45° field of view, color fundus image.
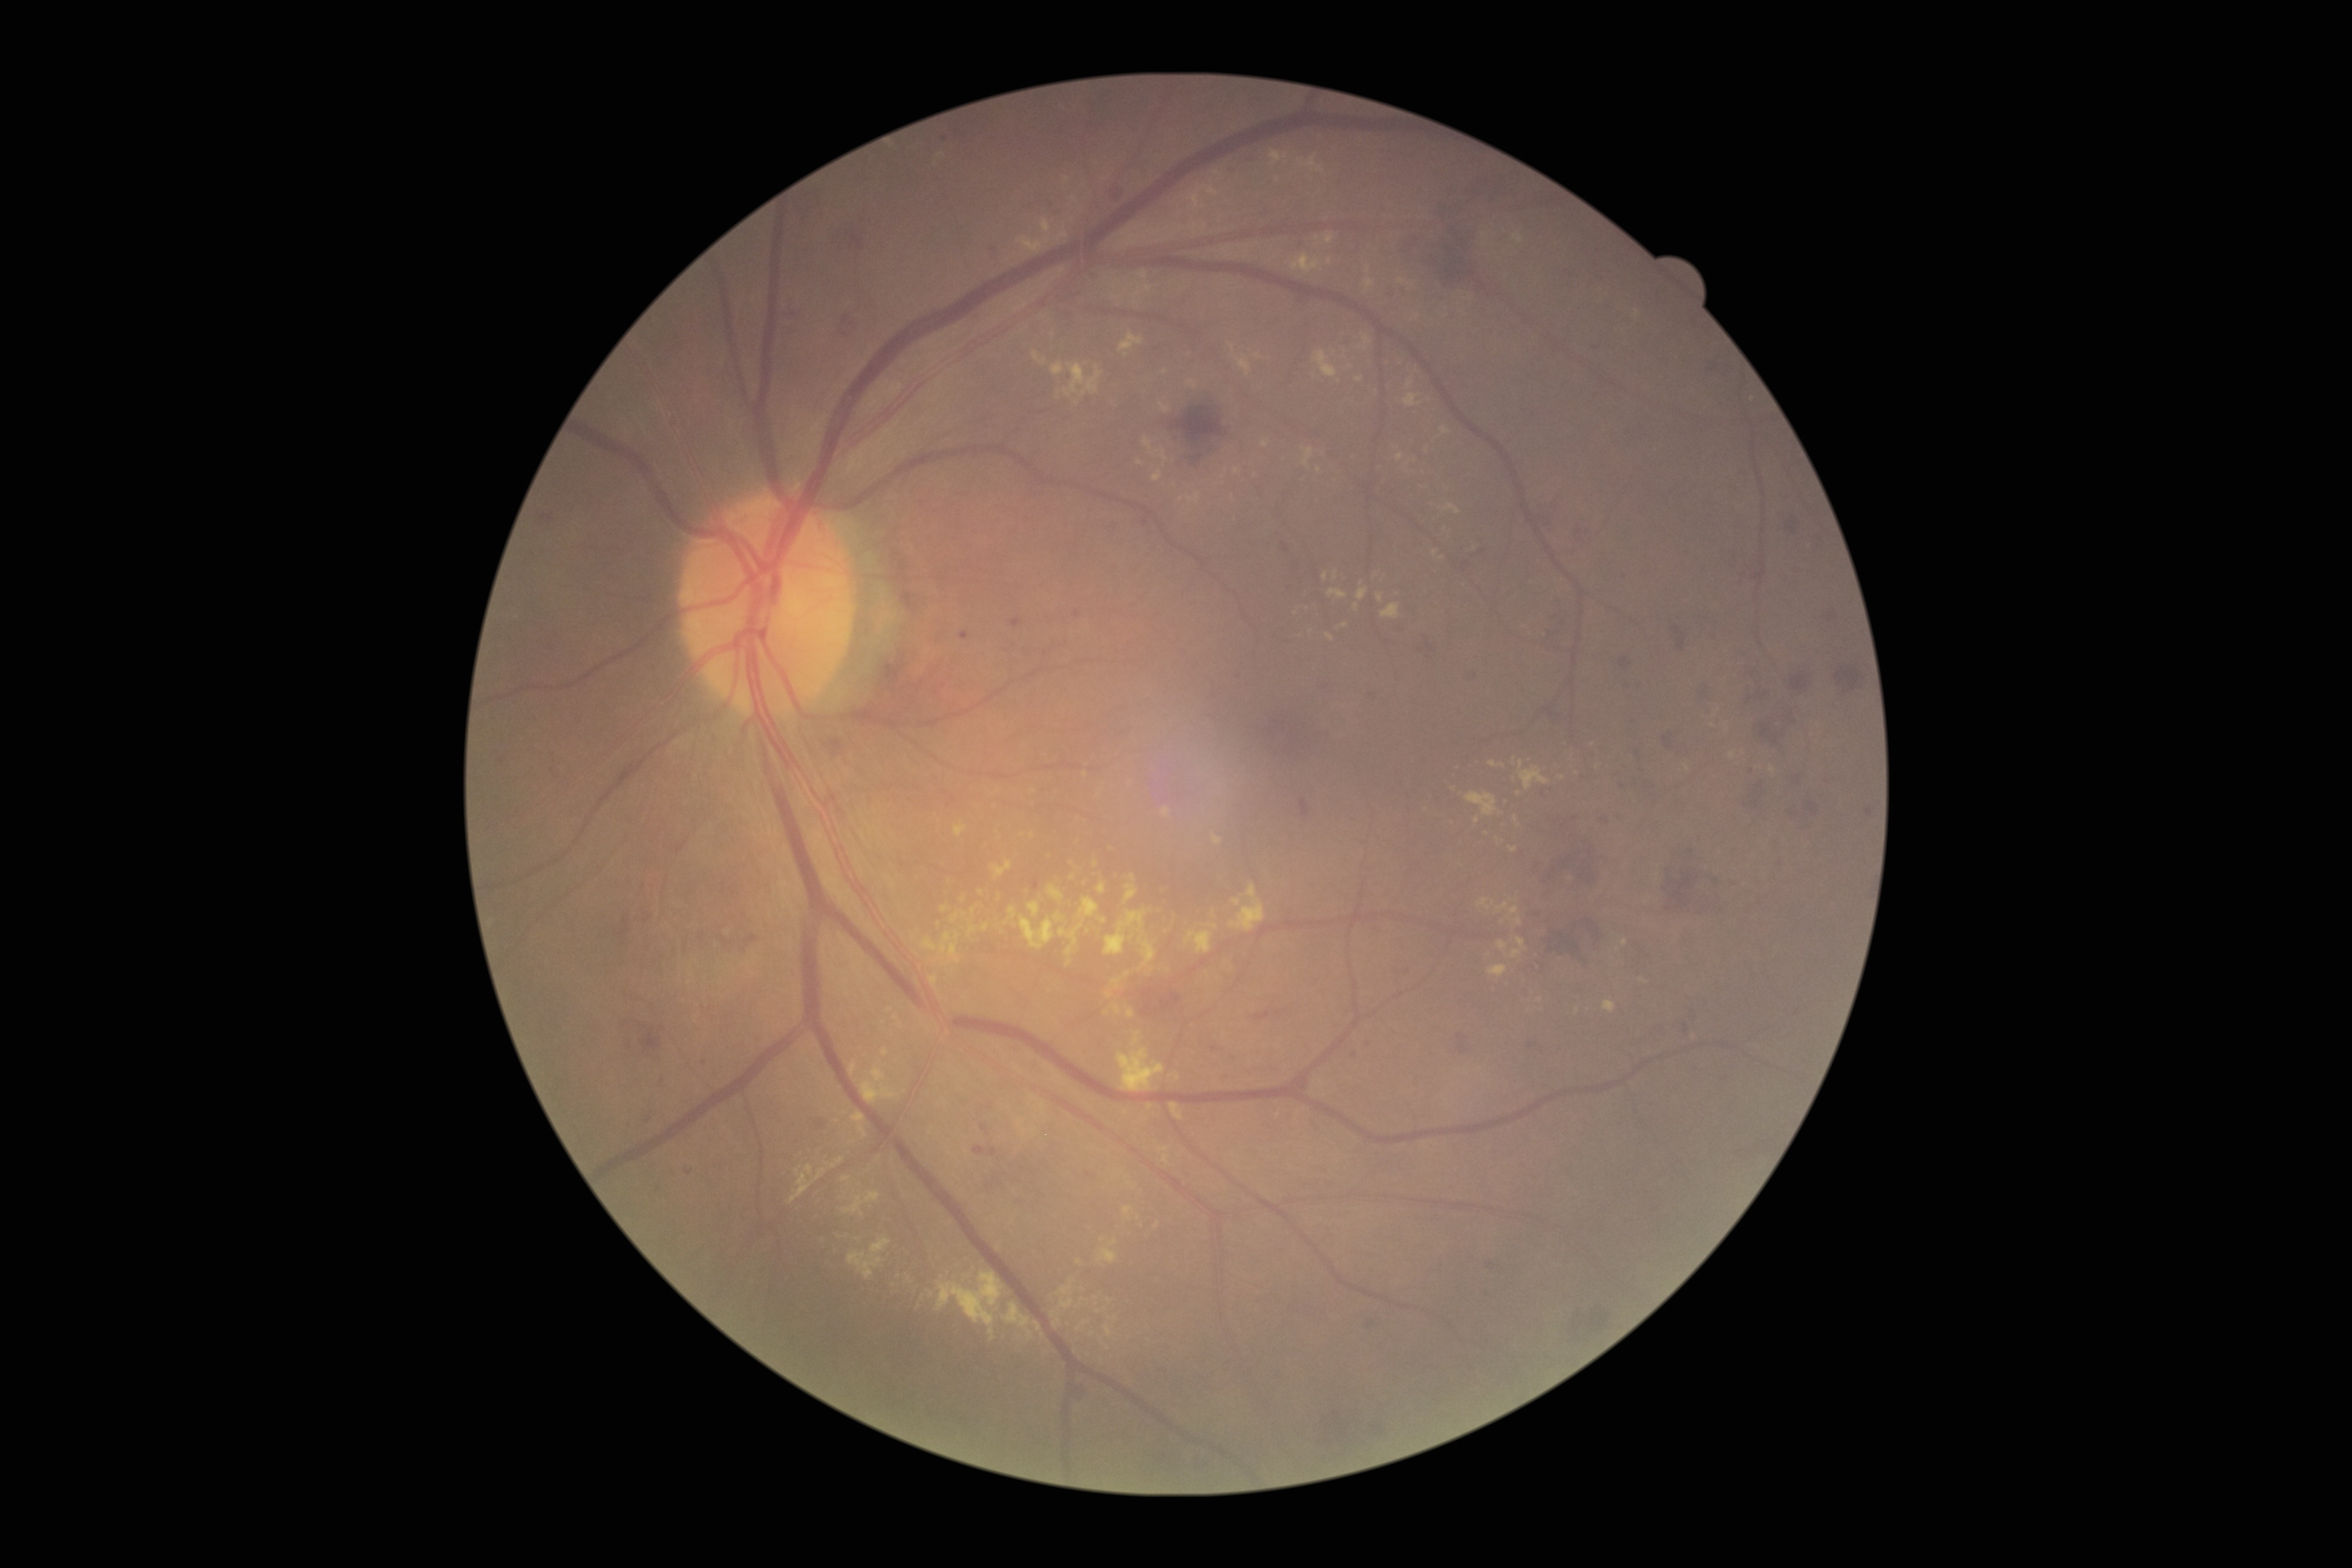

DR grade: 2 (moderate NPDR)
Selected lesions:
EXs (subset) = region(1325, 233, 1335, 245) | region(1497, 937, 1529, 959) | region(1478, 898, 1491, 909) | region(1396, 453, 1404, 462) | region(1503, 799, 1511, 804) | region(1125, 885, 1138, 903) | region(860, 1065, 900, 1104) | region(881, 1048, 889, 1056) | region(1162, 808, 1171, 818) | region(843, 1196, 863, 1217) | region(1059, 1298, 1074, 1310)
Small EXs approximately at Point(1516, 819) | Point(1540, 1000) | Point(1148, 289) | Point(1487, 833) | Point(1107, 1013) | Point(1092, 1334) | Point(1688, 769)